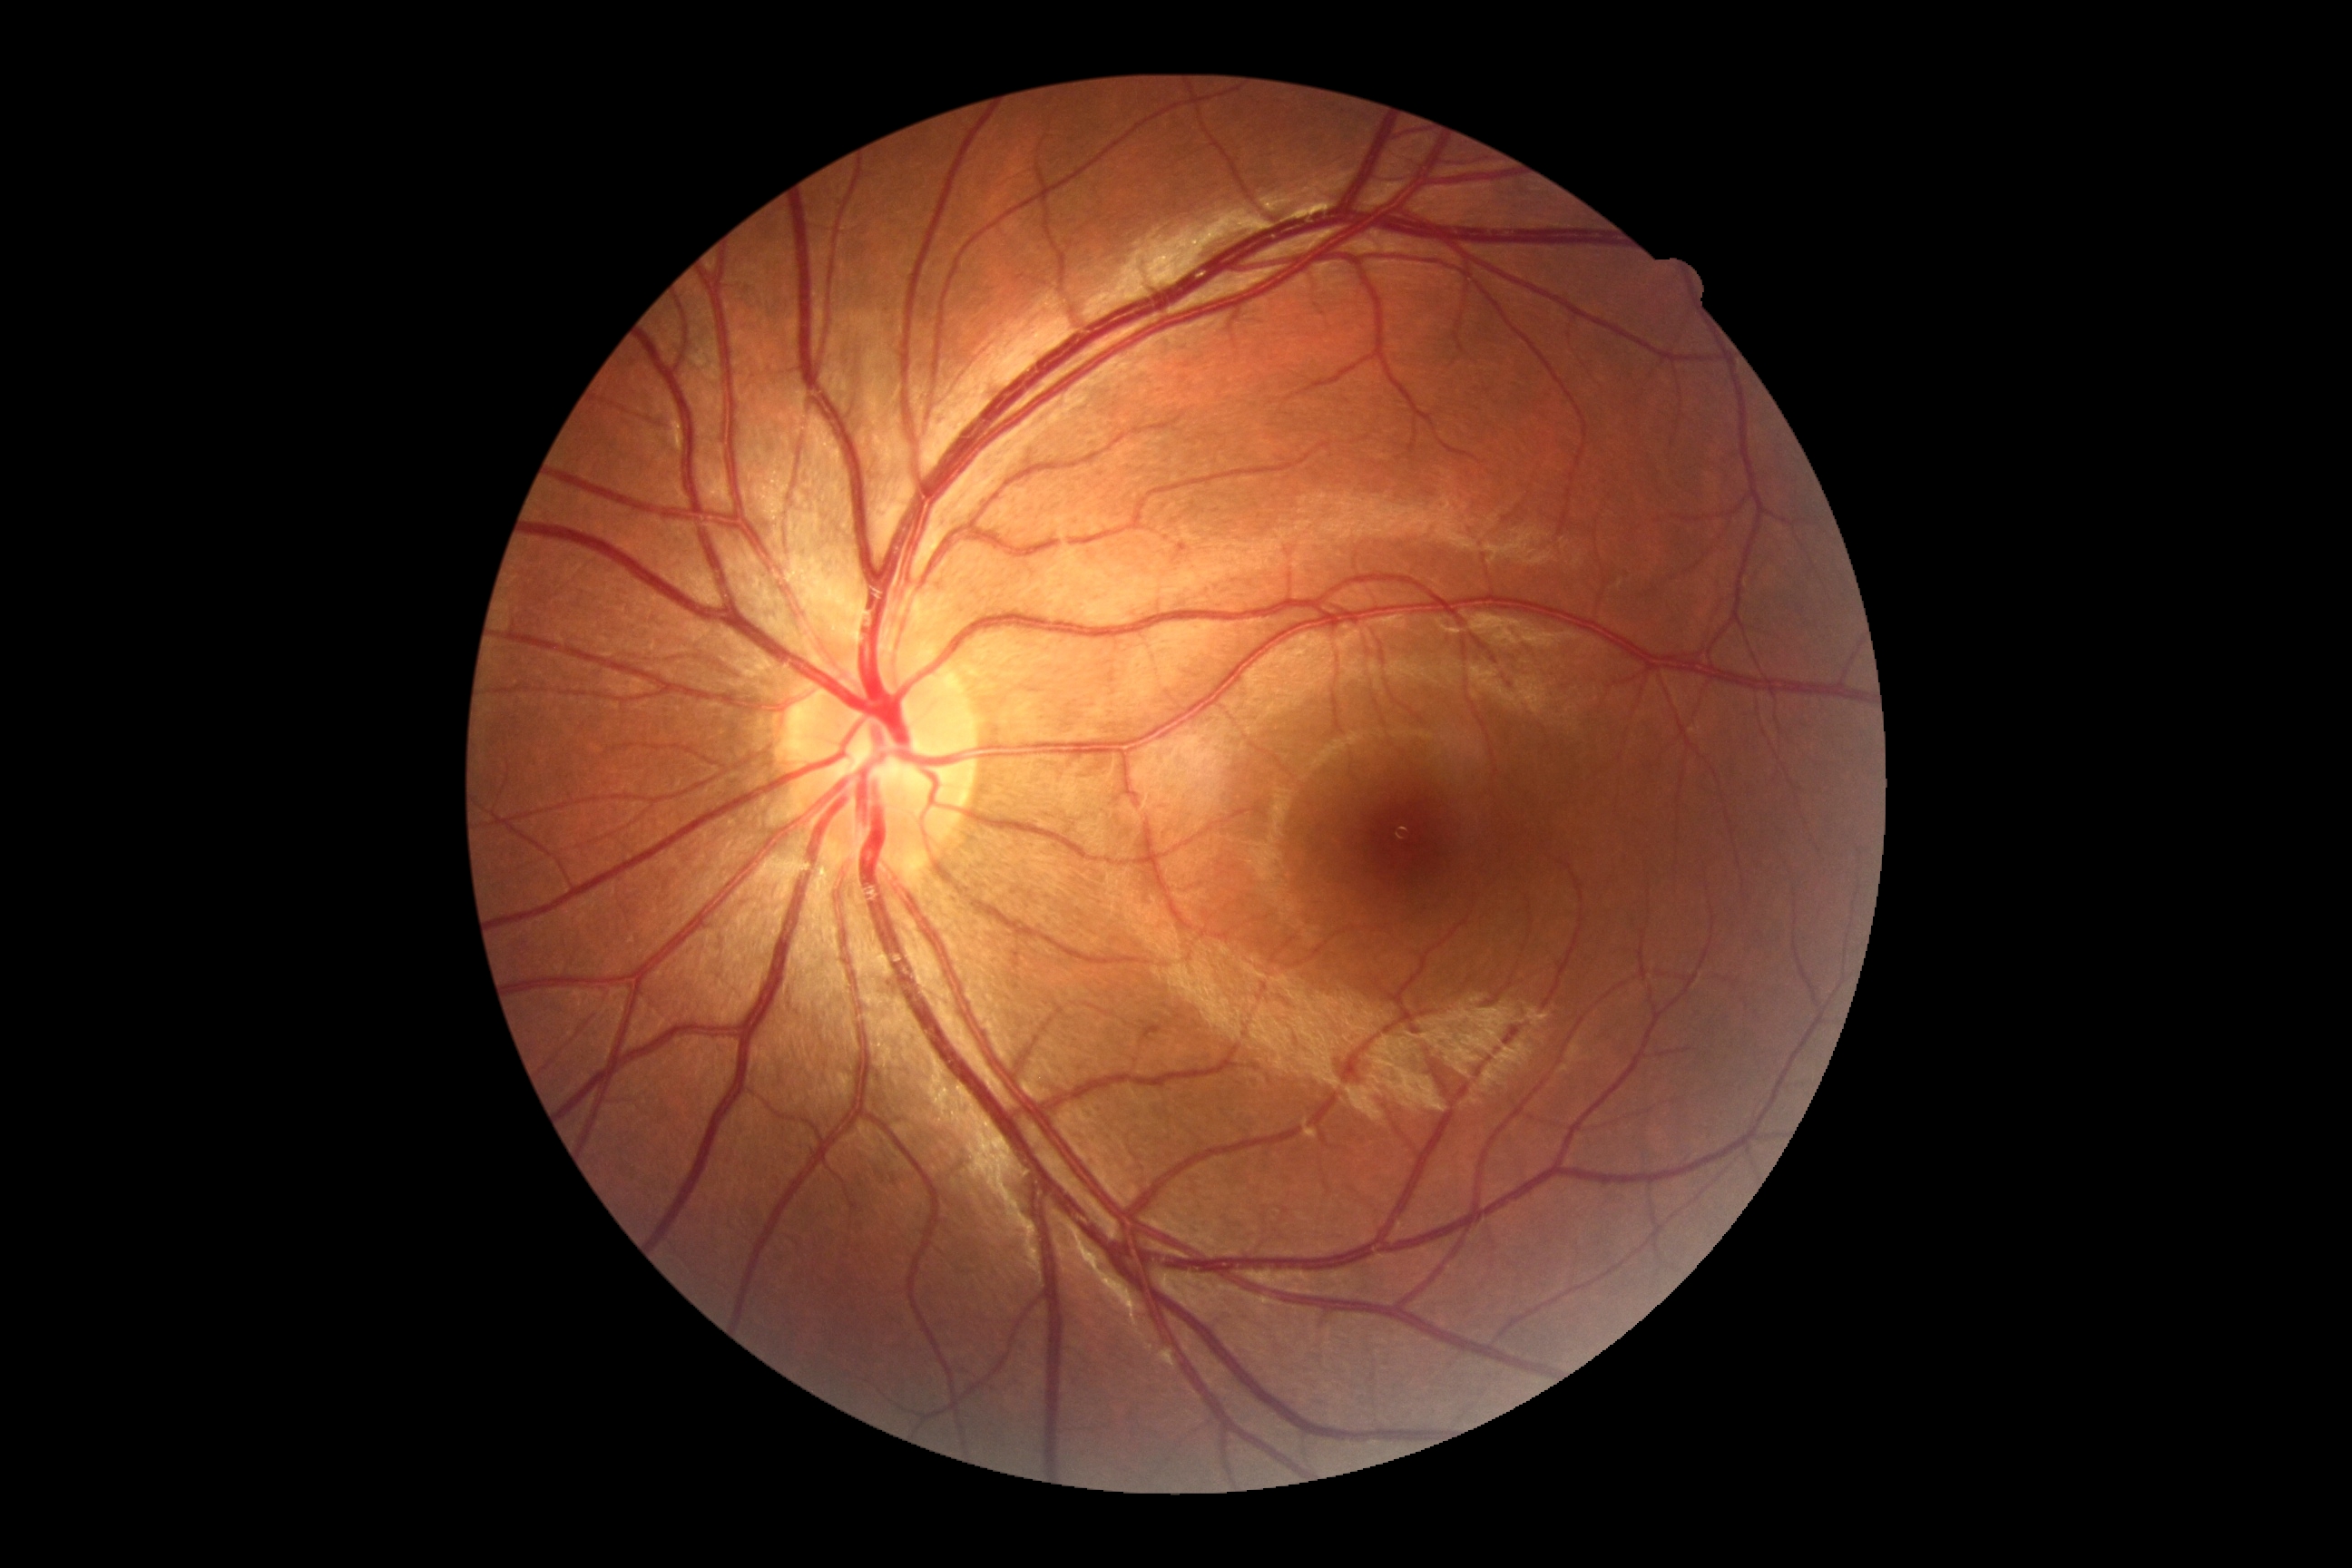 retinopathy grade=0 — no visible signs of diabetic retinopathy.